Camera: Phoenix ICON (100° FOV) · wide-field fundus photograph from neonatal ROP screening.
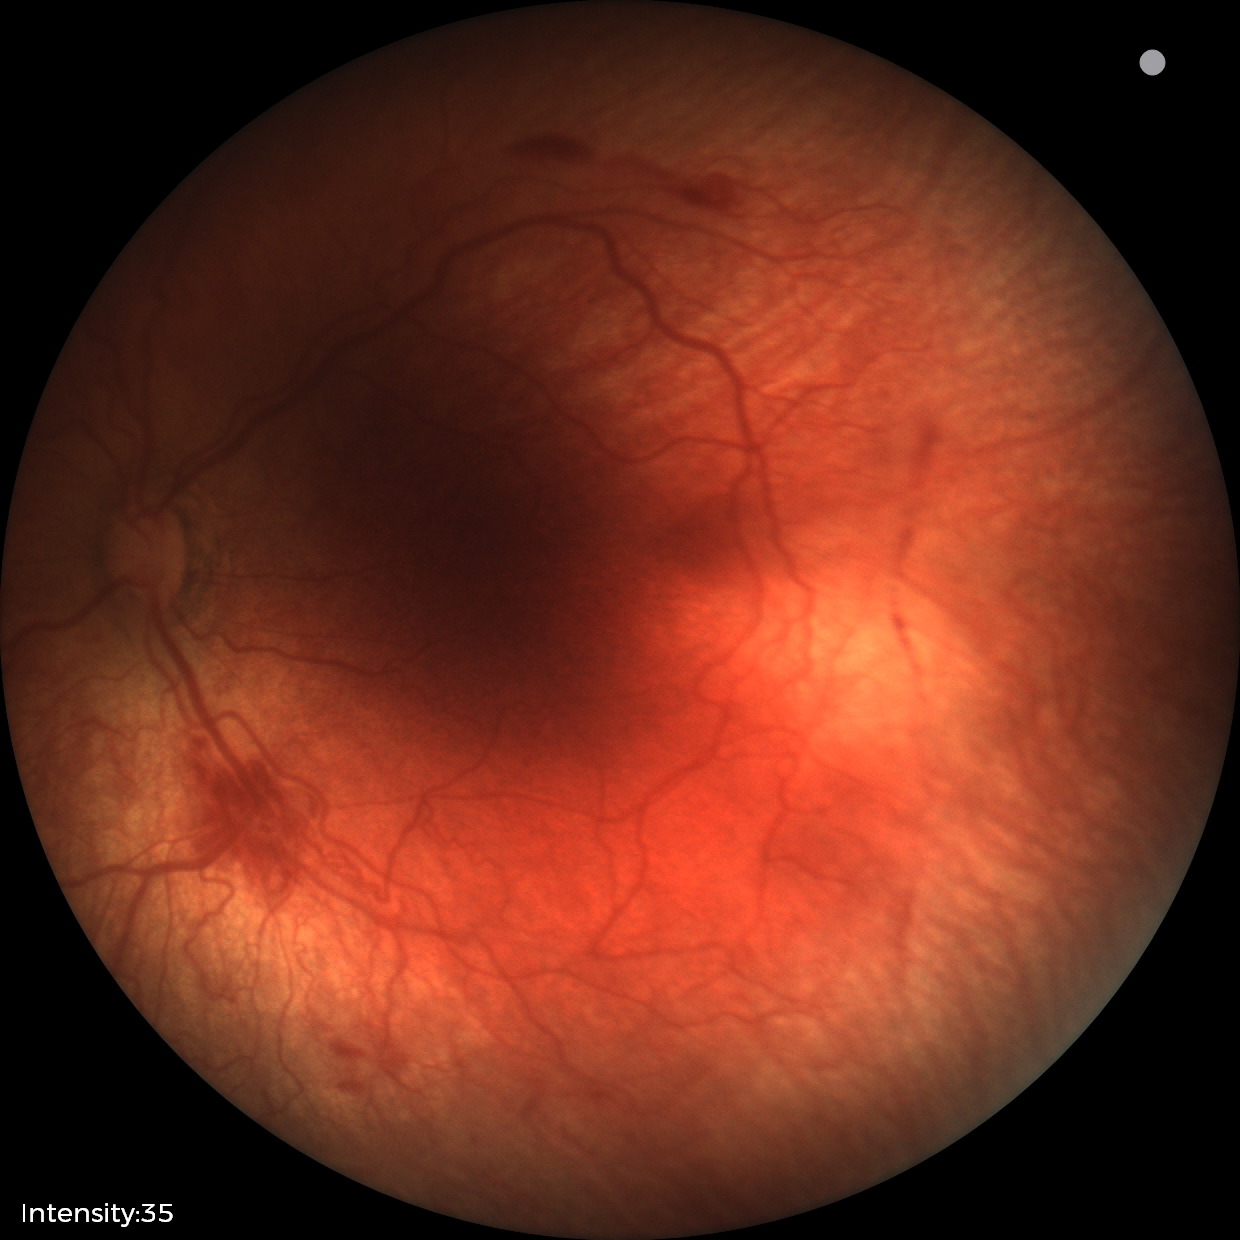 Screening: retinopathy of prematurity (ROP) stage 2 | plus disease.